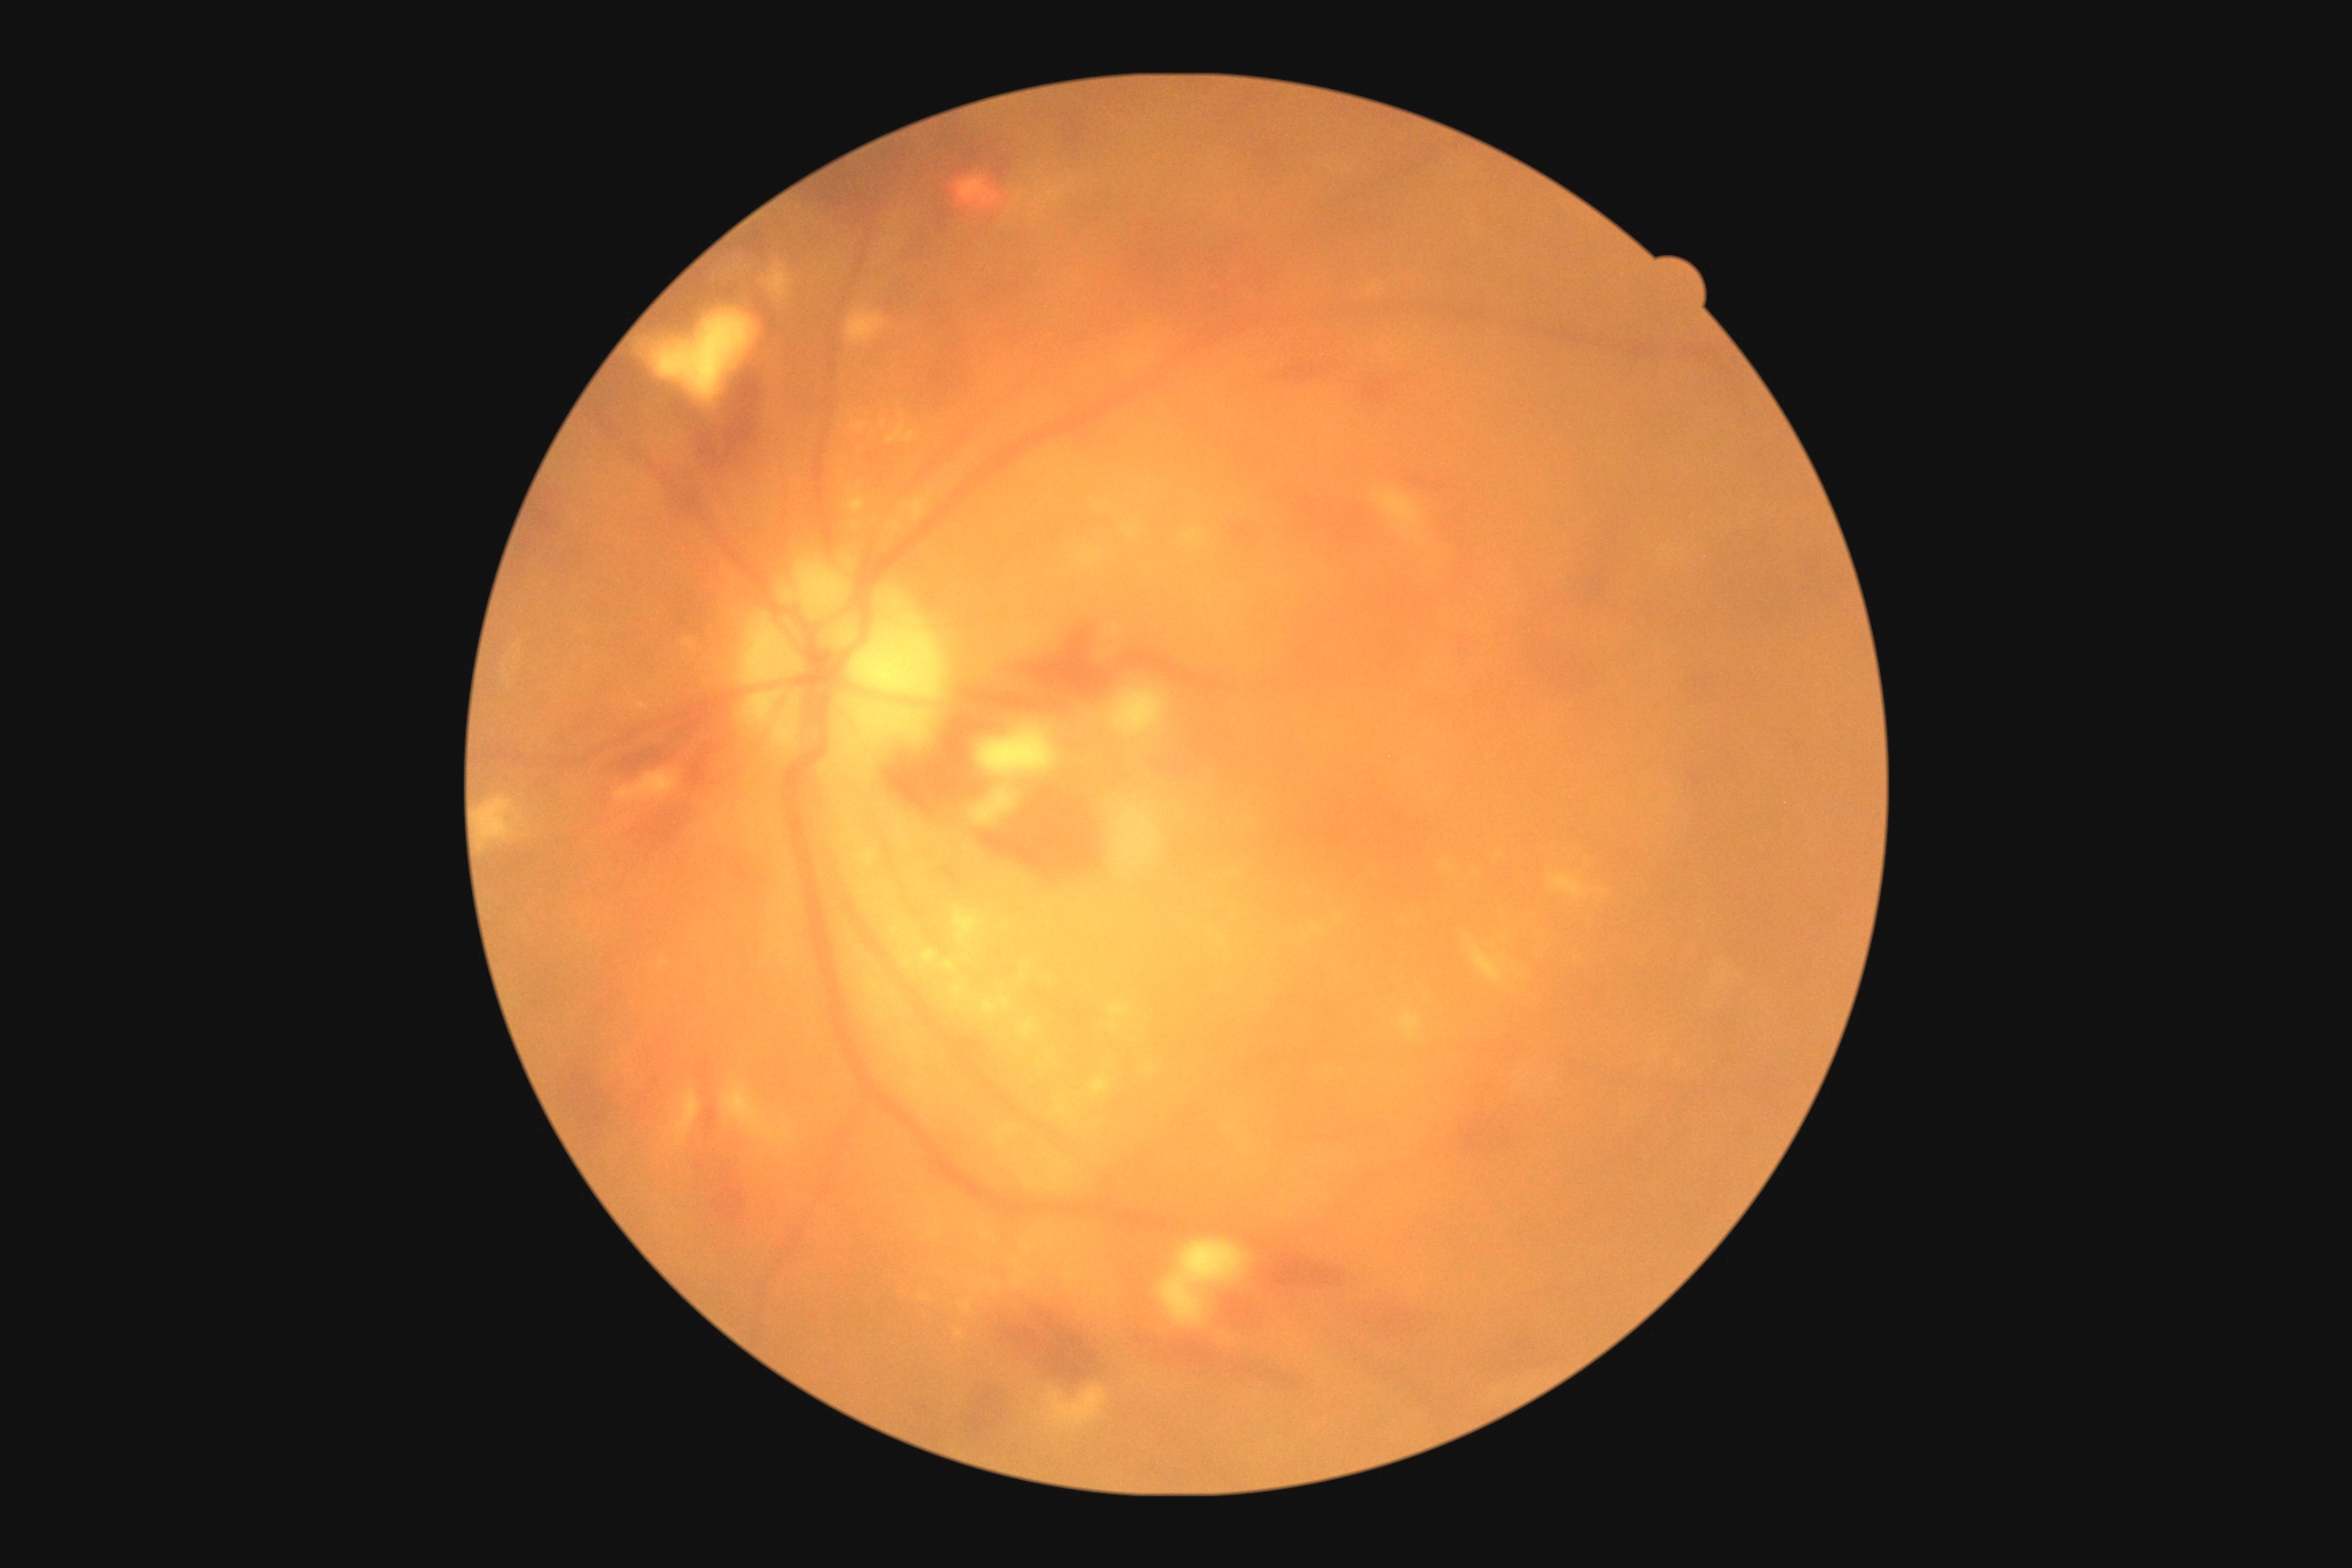

diabetic retinopathy grade: 2.